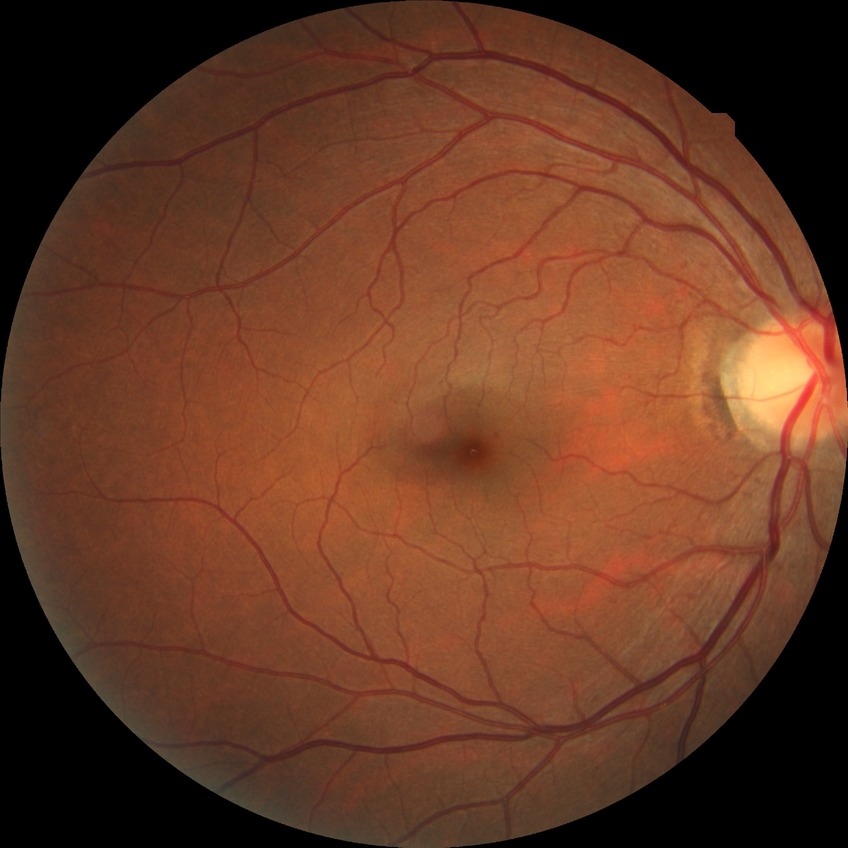 Diabetic retinopathy grade is no diabetic retinopathy.